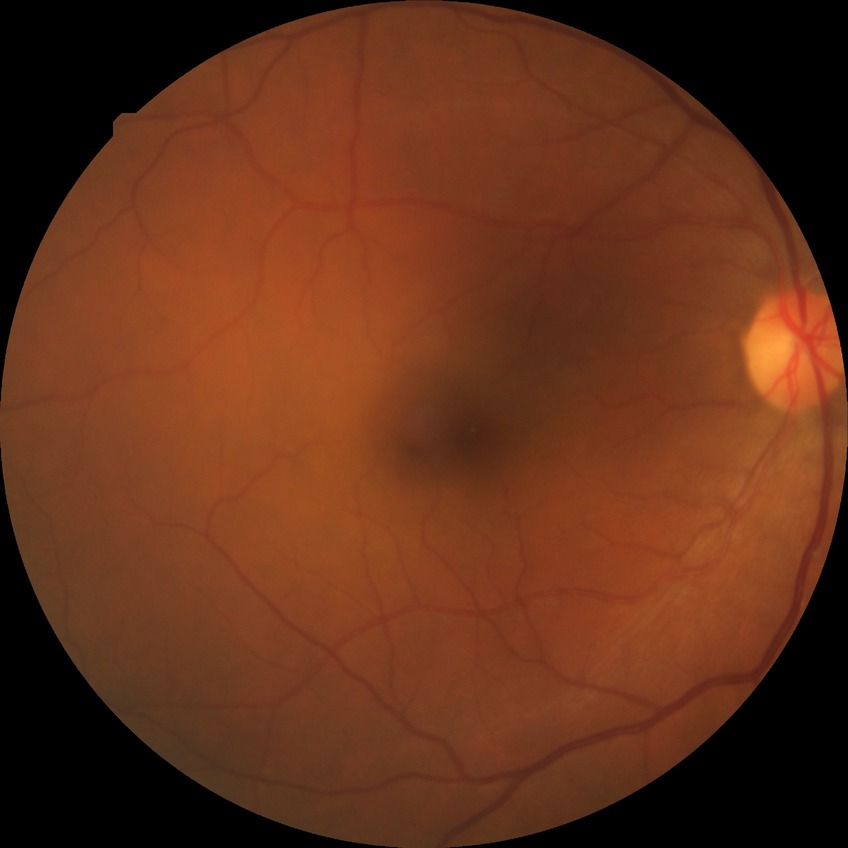

Diabetic retinopathy (DR) is no diabetic retinopathy (NDR).